45° field of view; image size 2352x1568 — 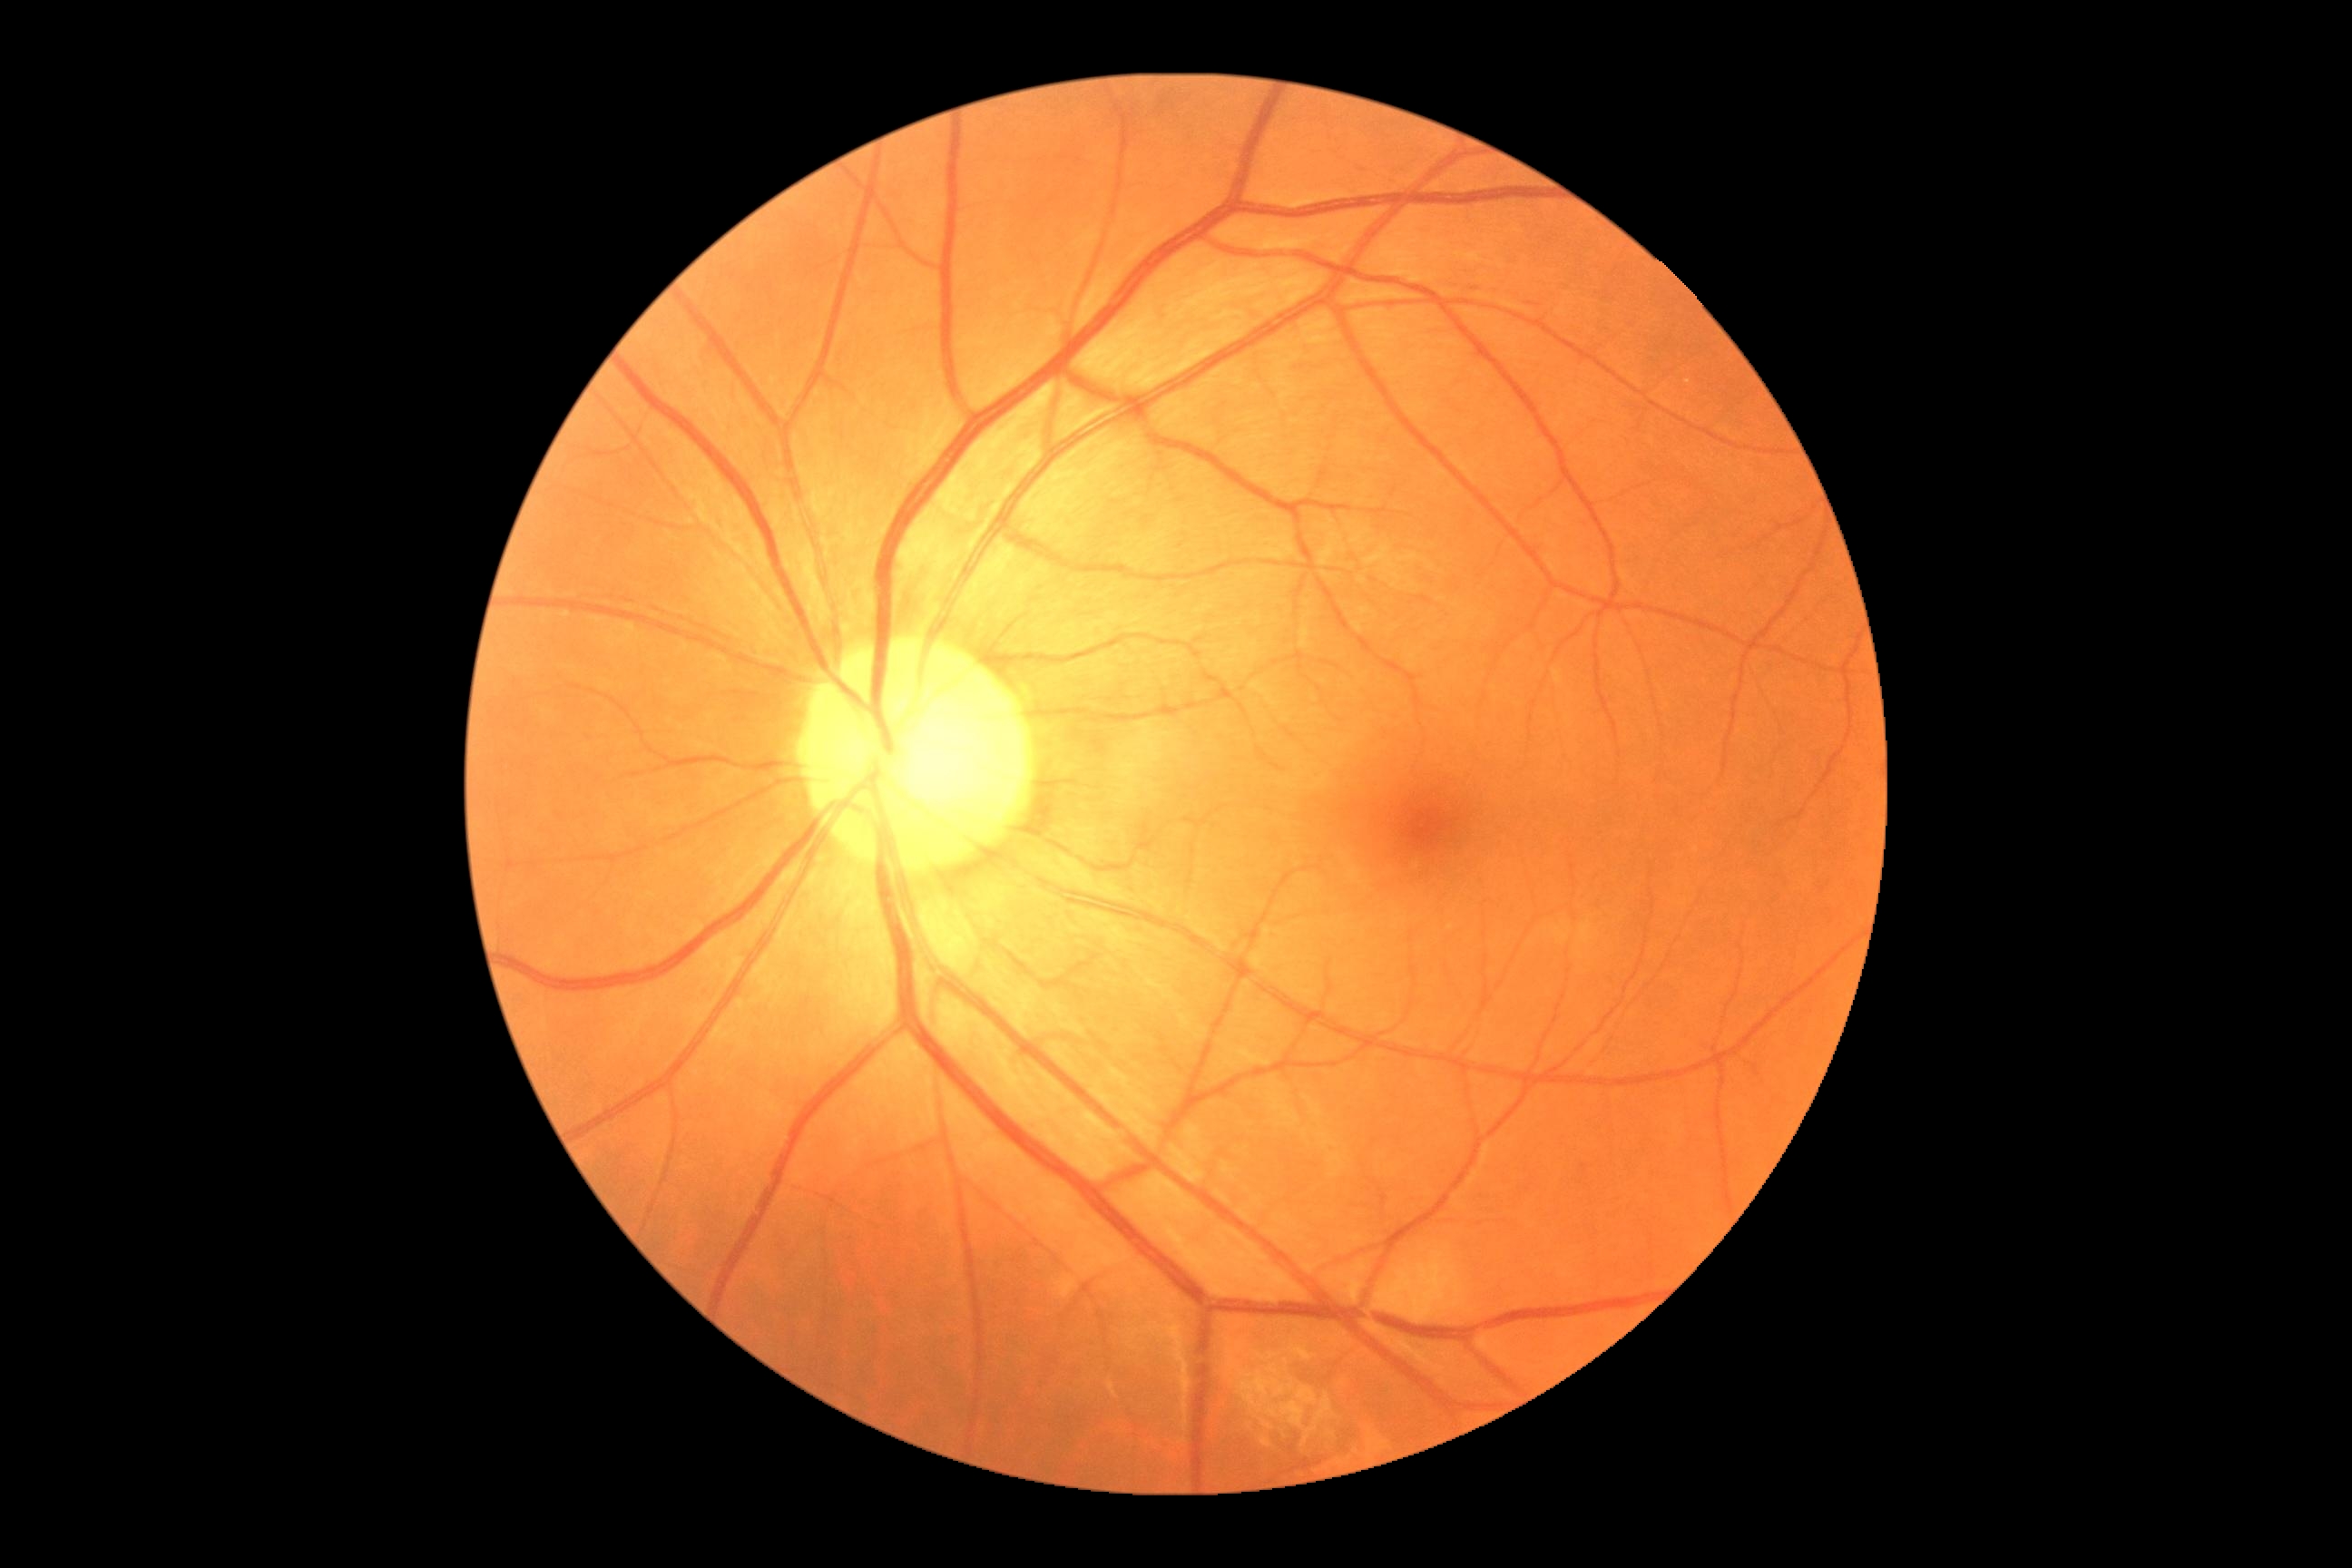
Diabetic retinopathy (DR): 0.